Fundus photo — 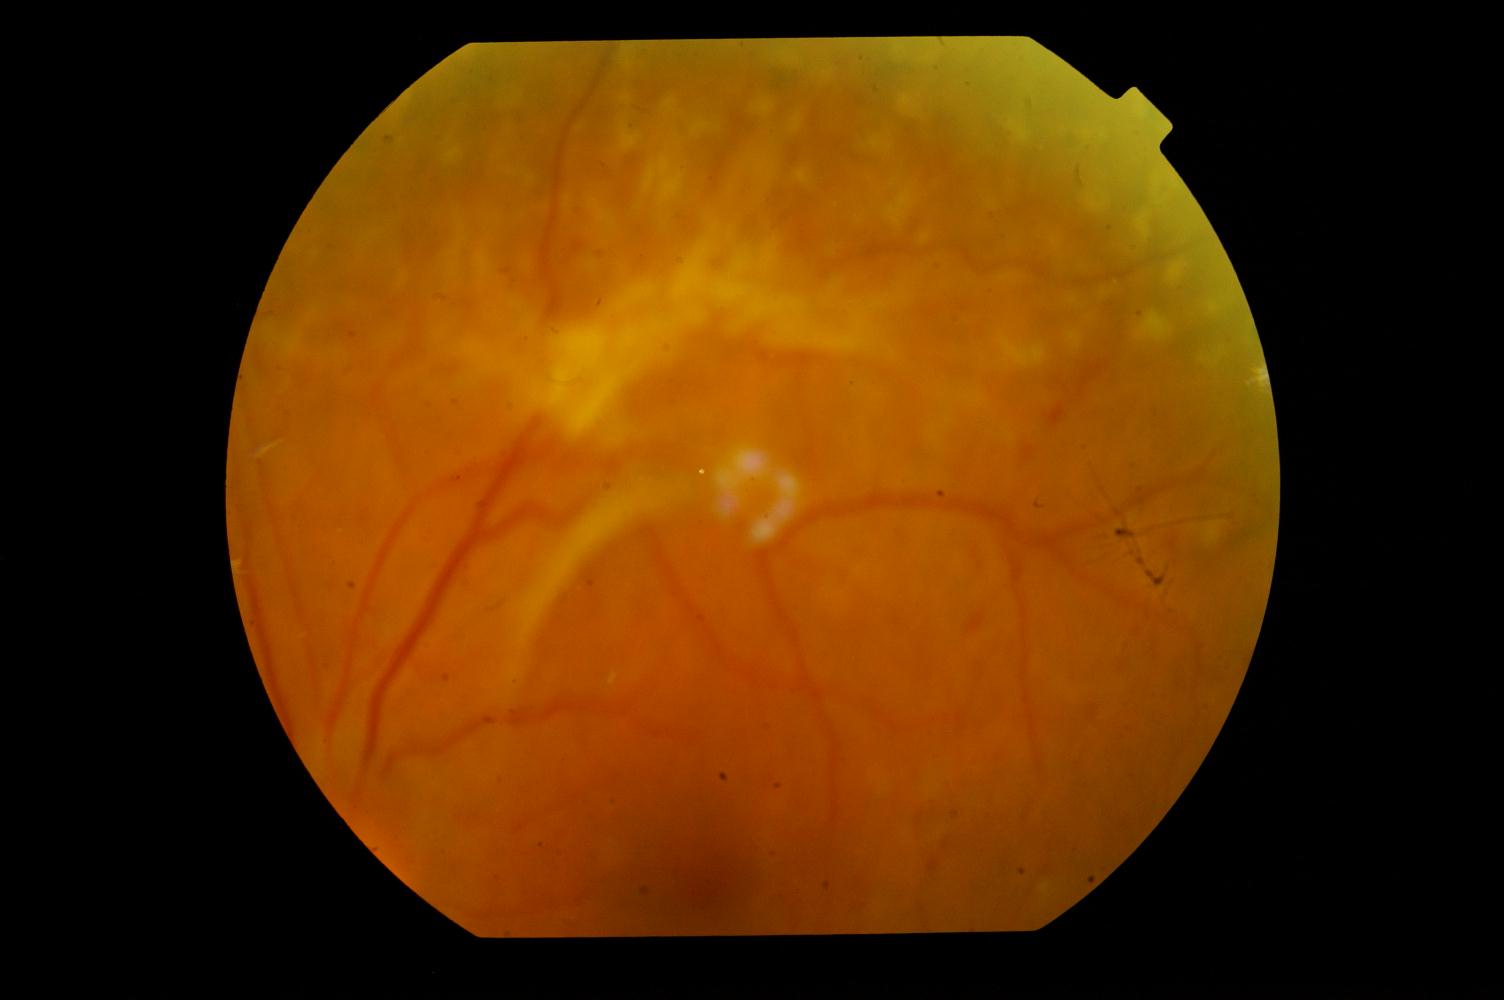
The image shows diabetic retinopathy (DR).